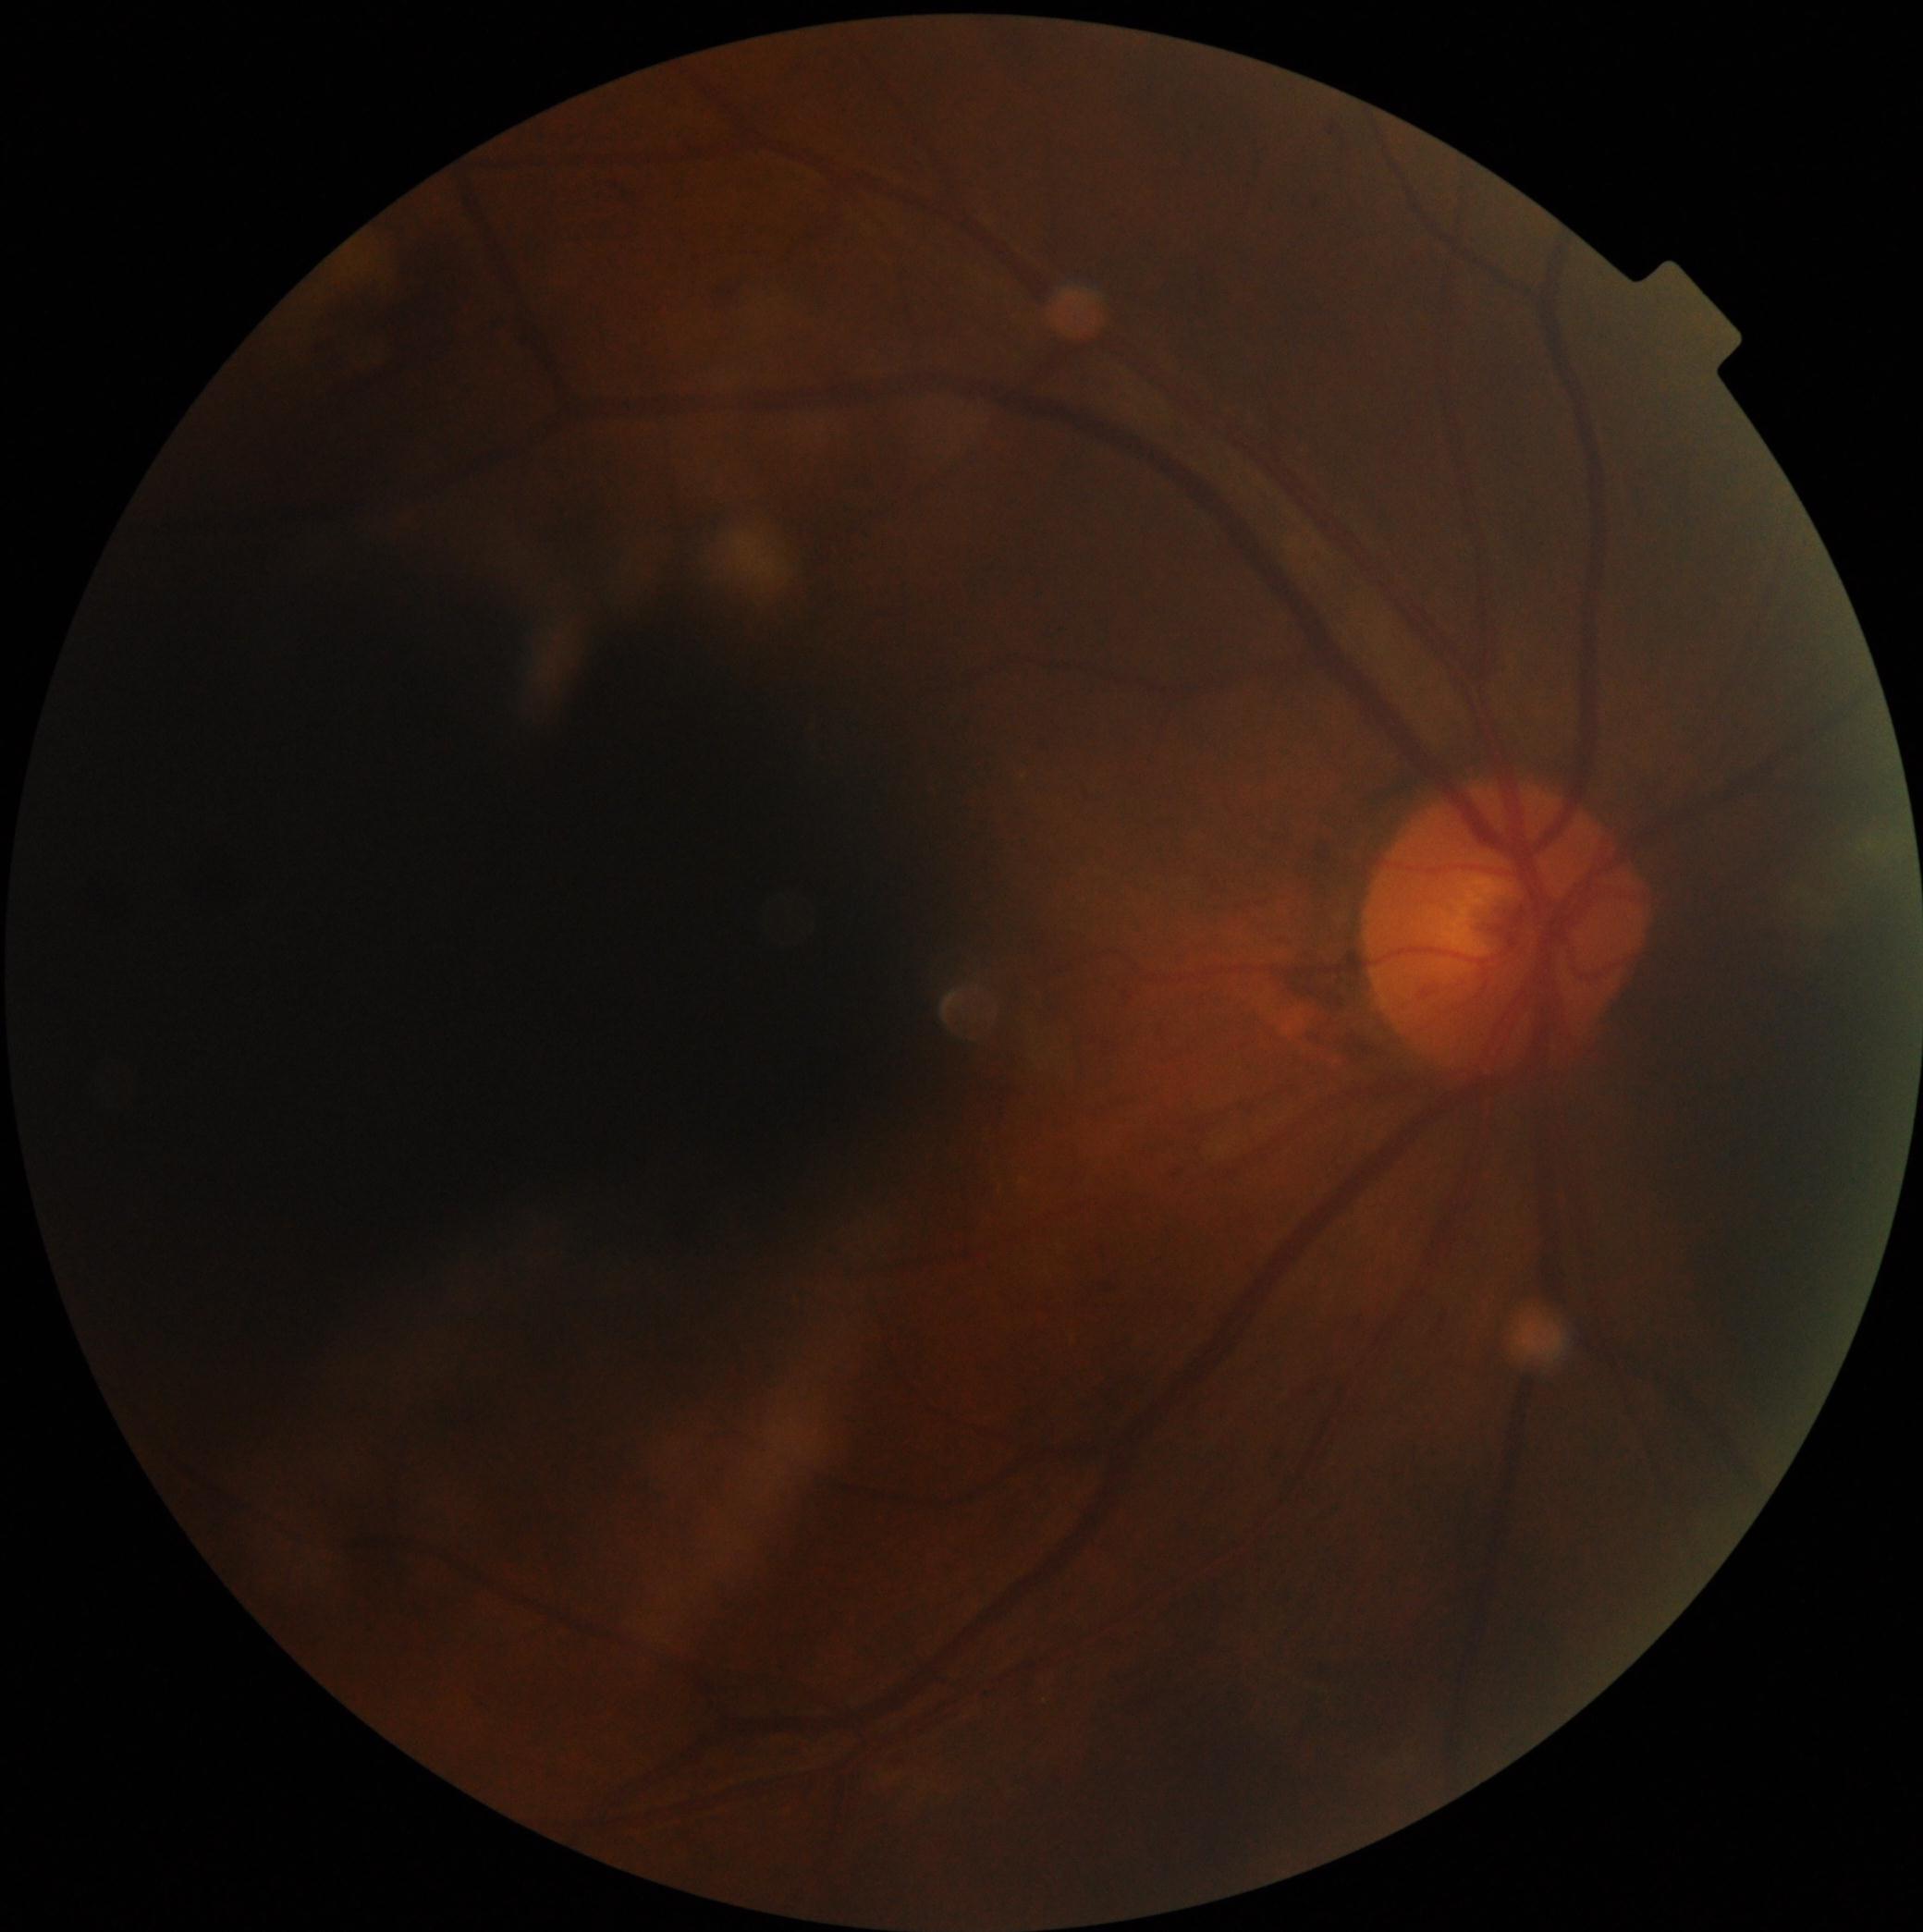 Diabetic retinopathy (DR) is 2/4.